Captured on a Remidio Fundus on Phone (FOP) camera — 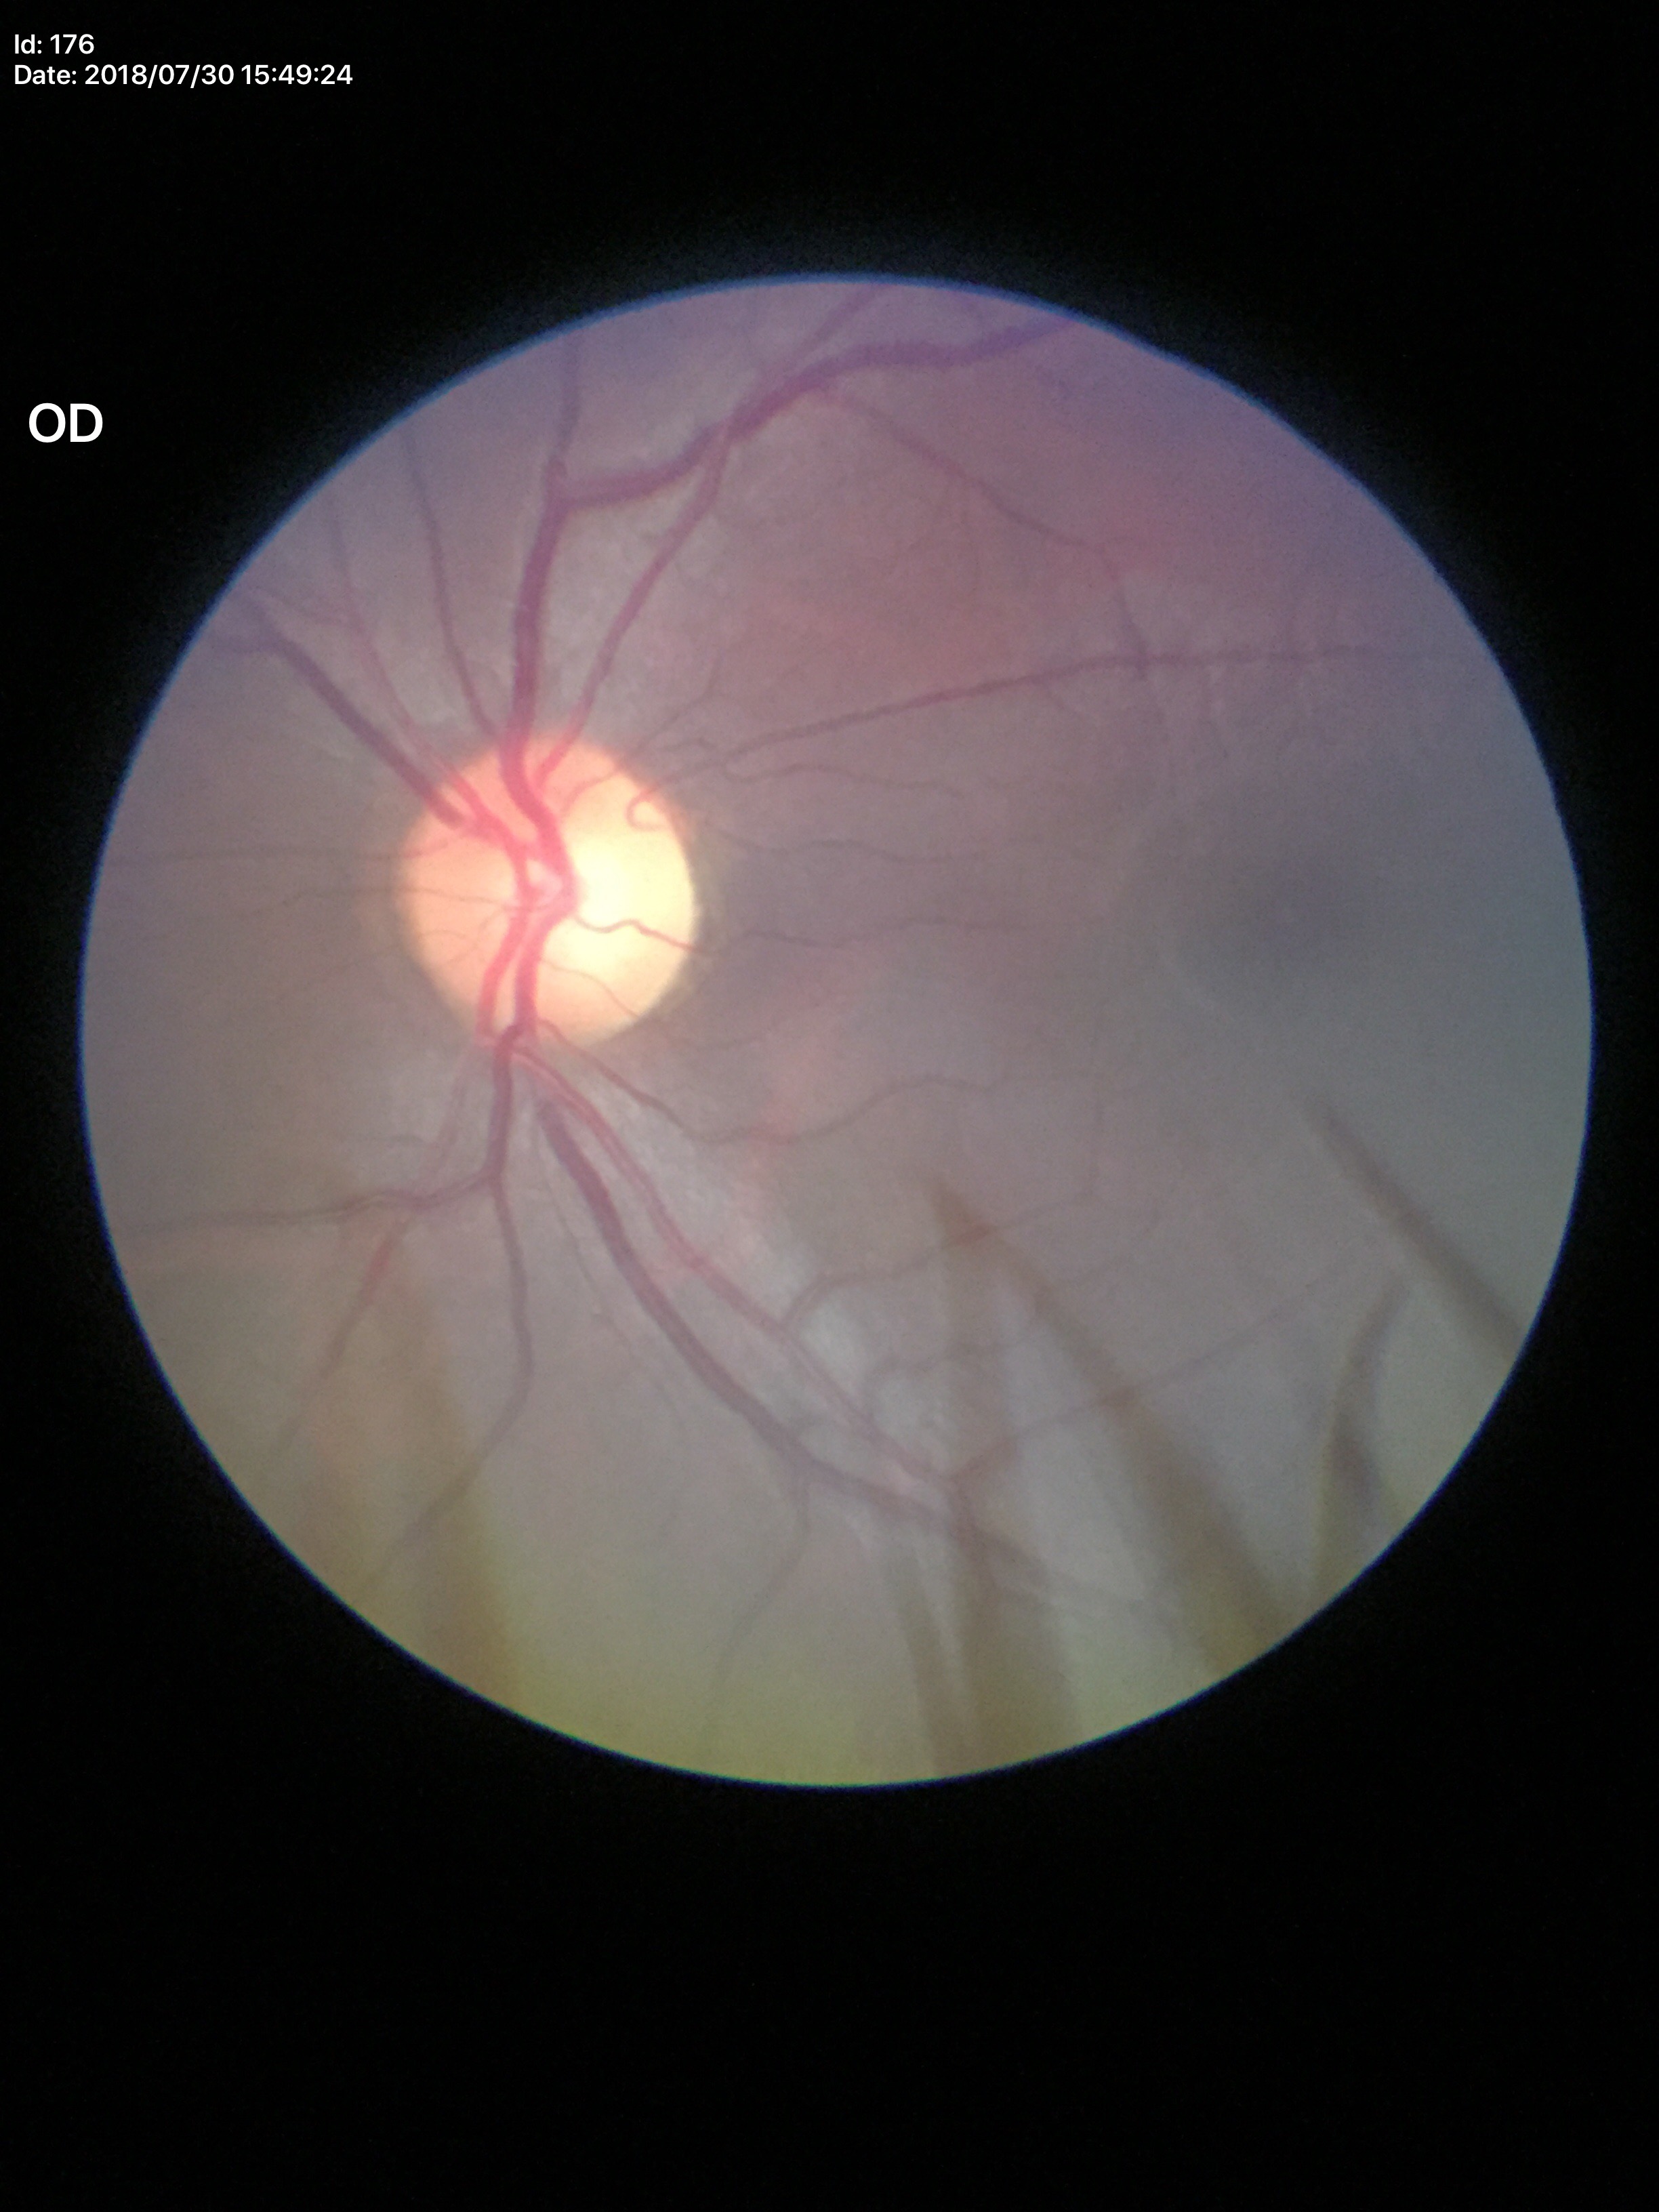

{
  "glaucoma_decision": "no suspicious findings",
  "vcdr": "0.54"
}